Wide-field contact fundus photograph of an infant:
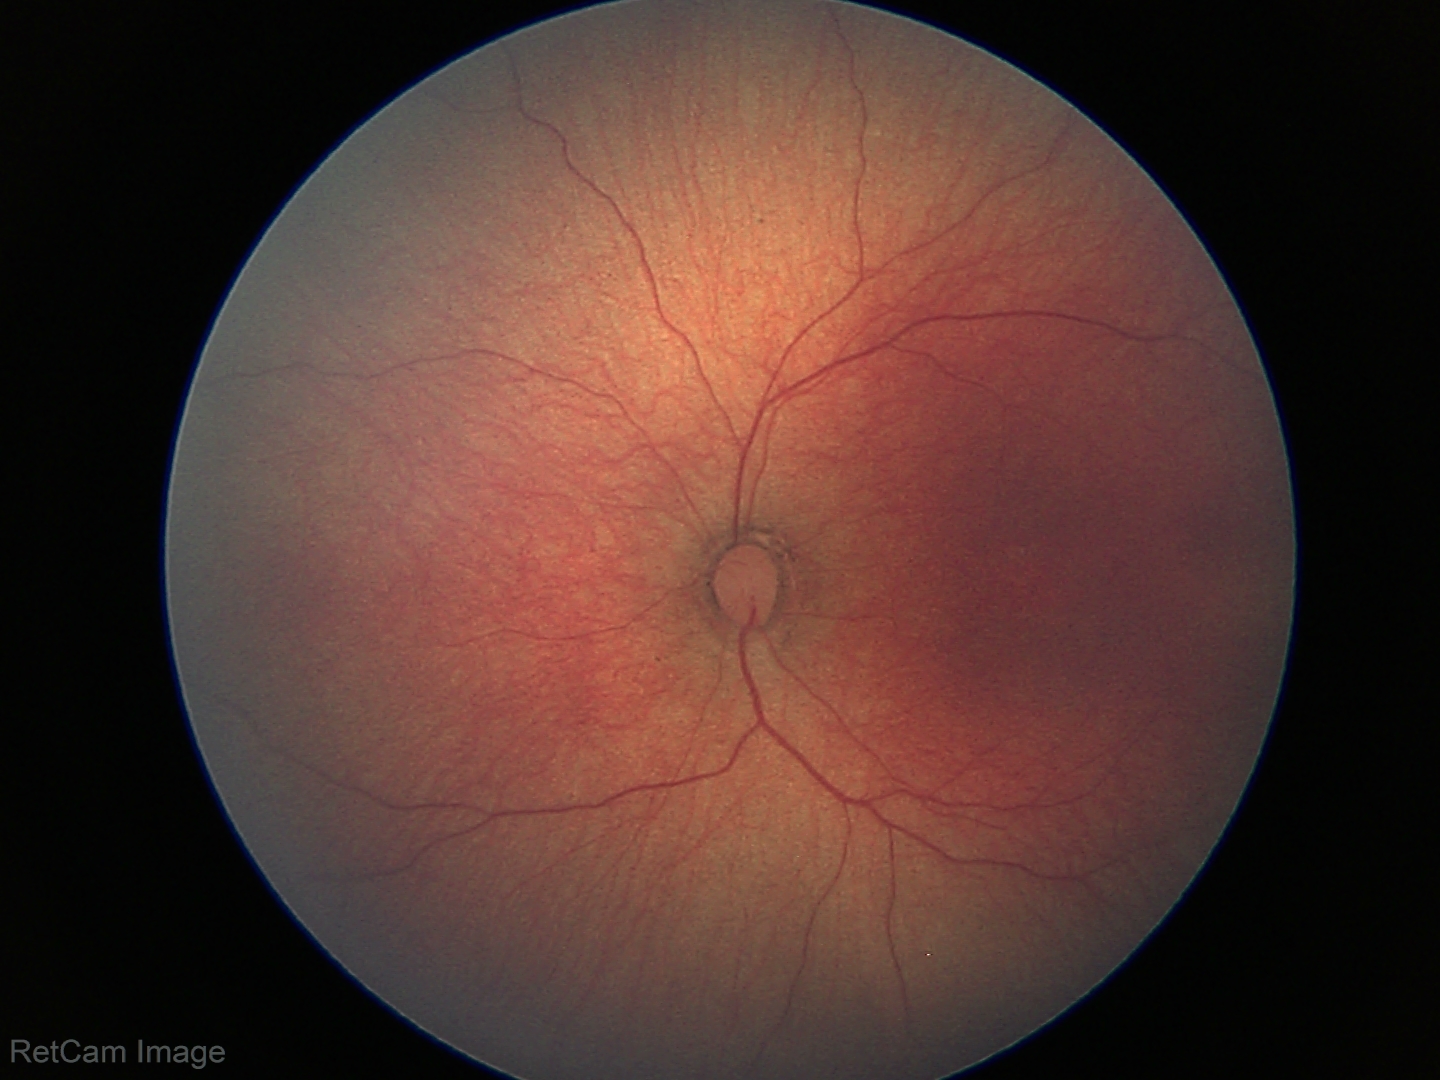 Physiological retinal appearance for postconceptual age.